Infant wide-field fundus photograph; 640x480
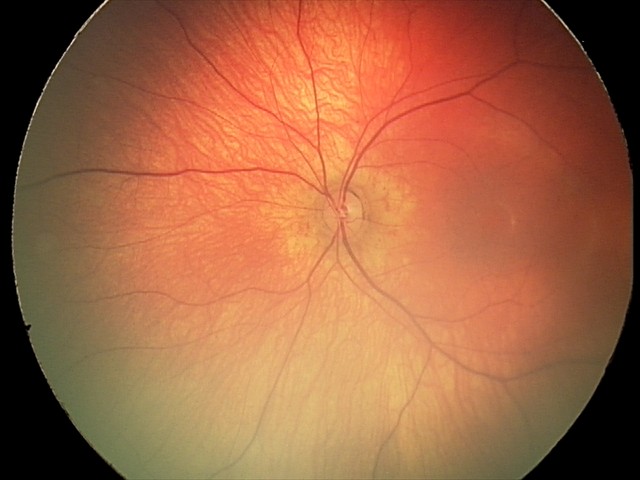
Assessment = physiological.